Color fundus image. 45-degree field of view. 2352x1568px: 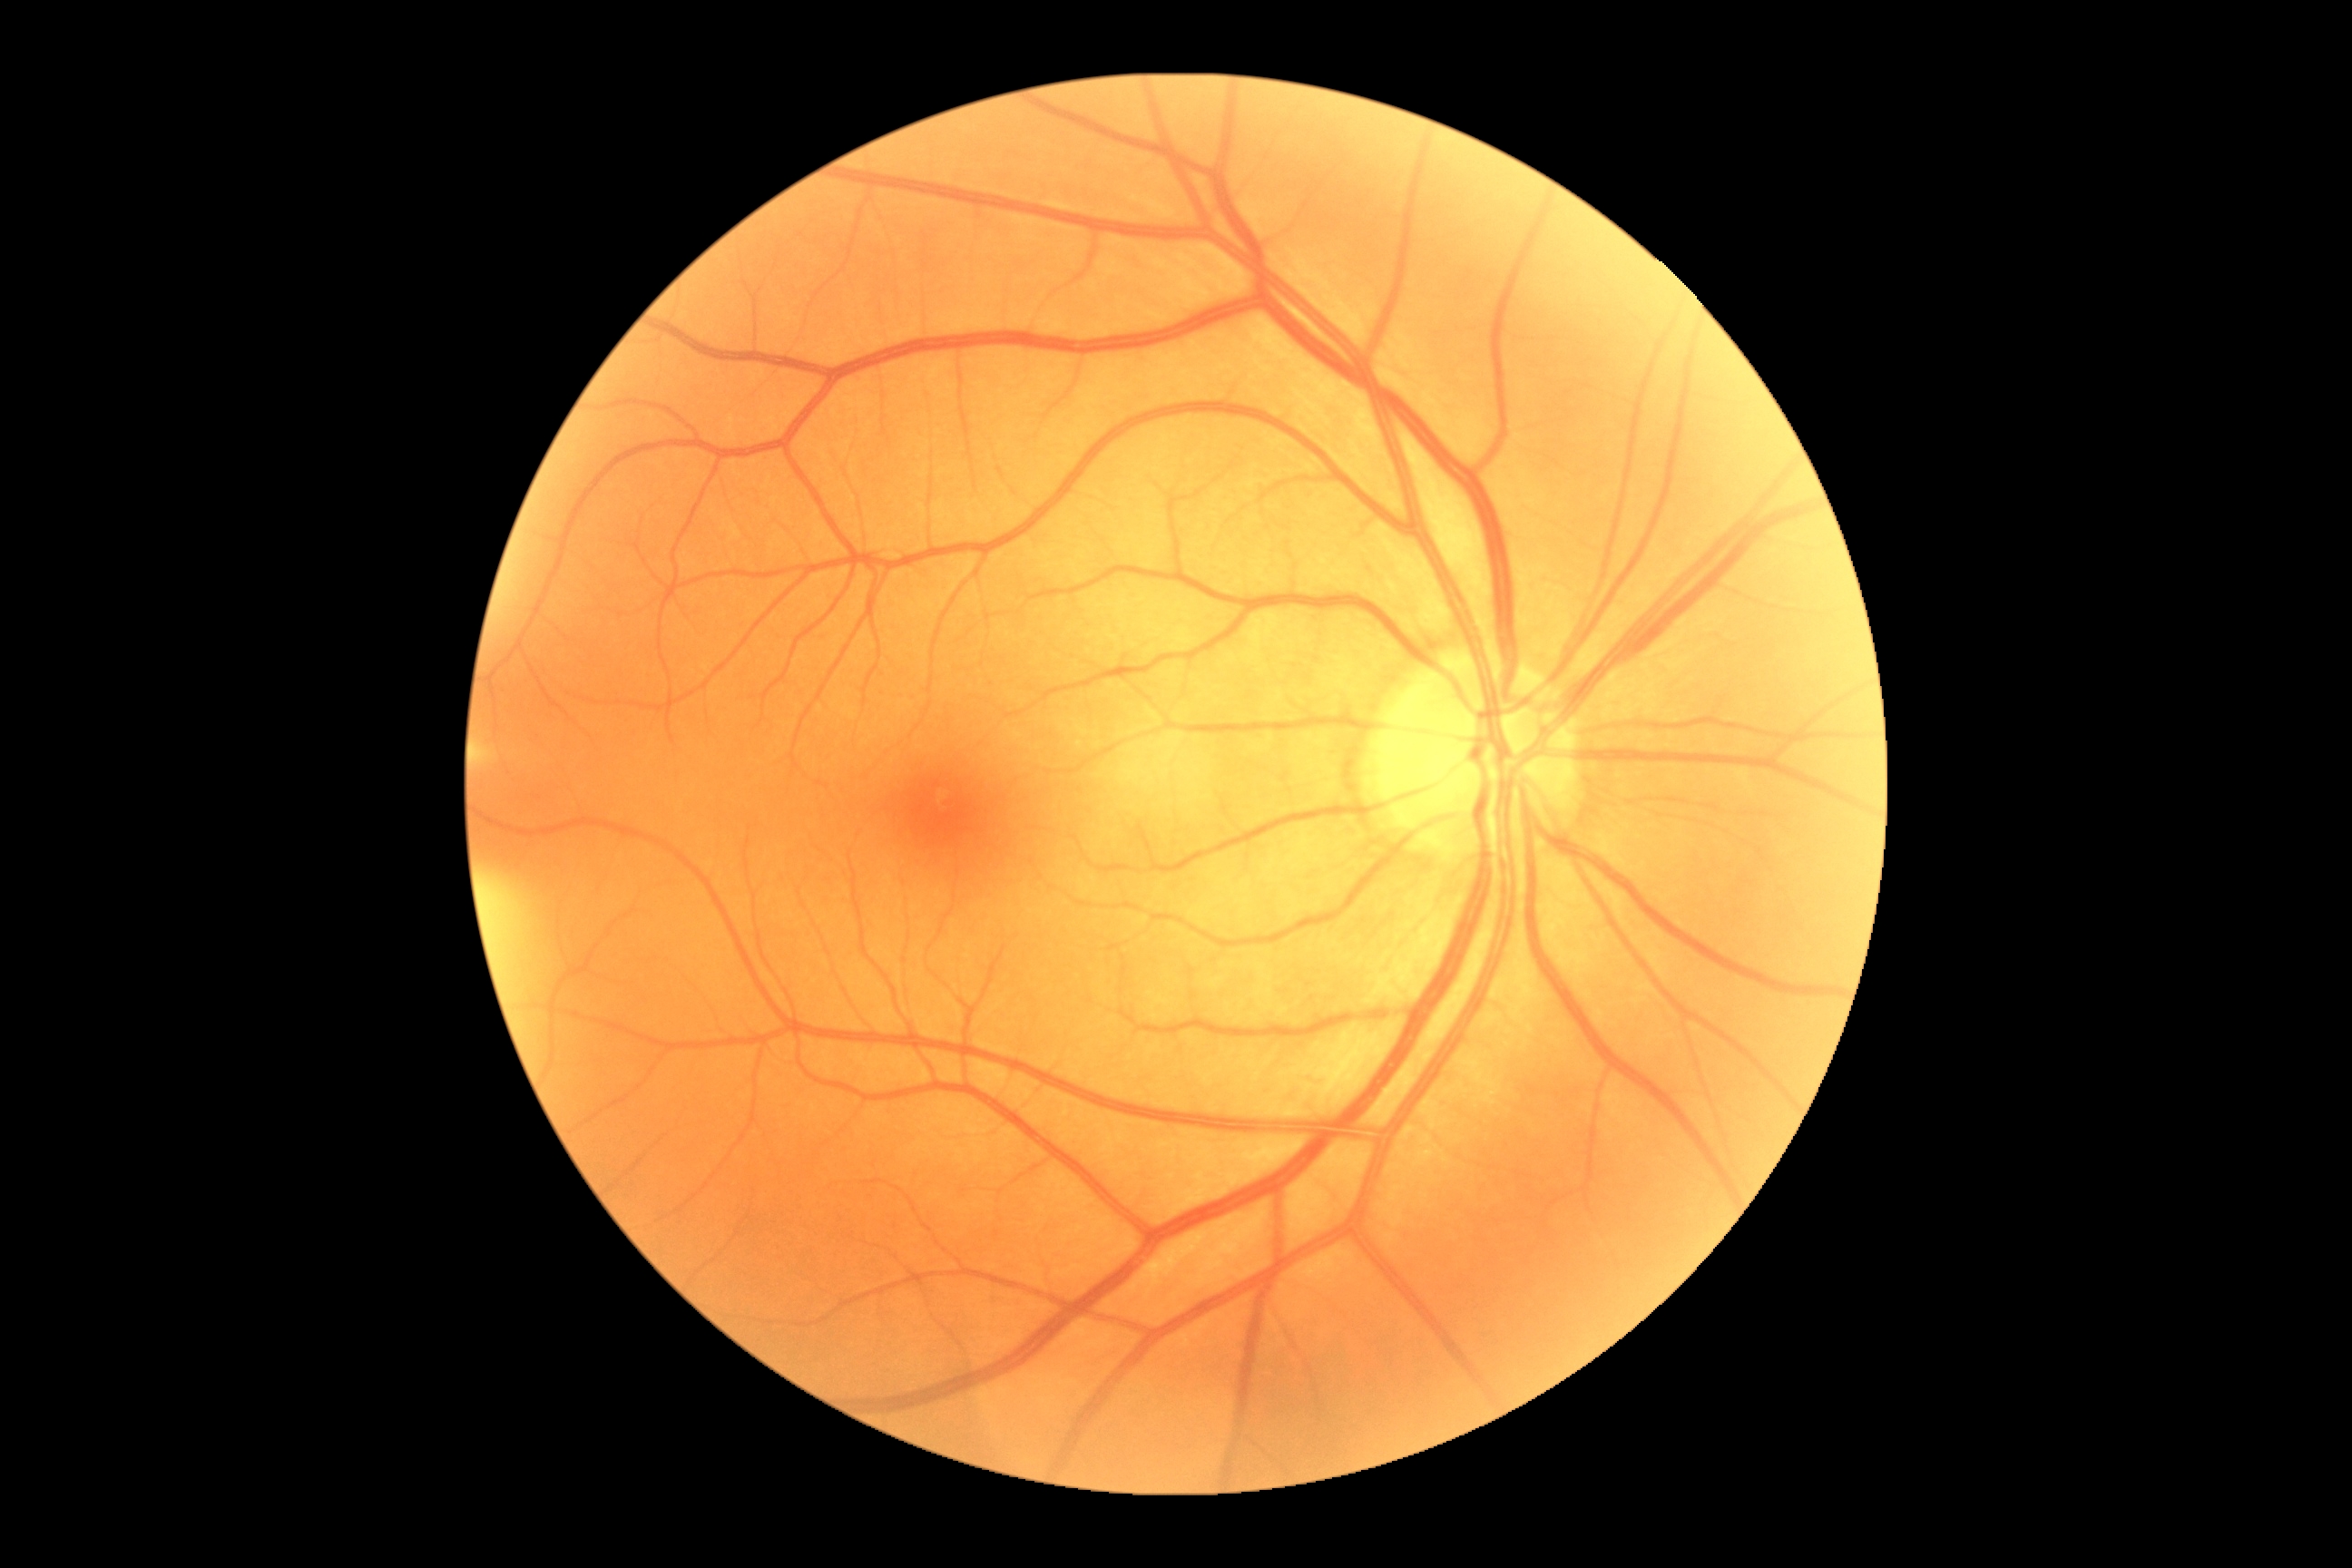 DR grade is 0.